Wide-field fundus photograph from neonatal ROP screening:
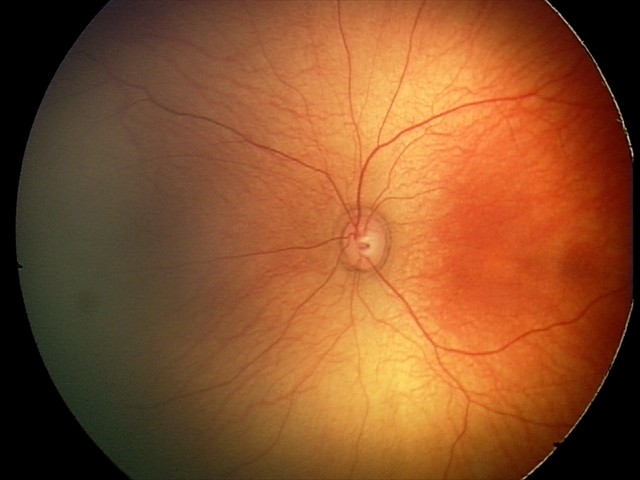

Physiological retinal appearance for postconceptual age.